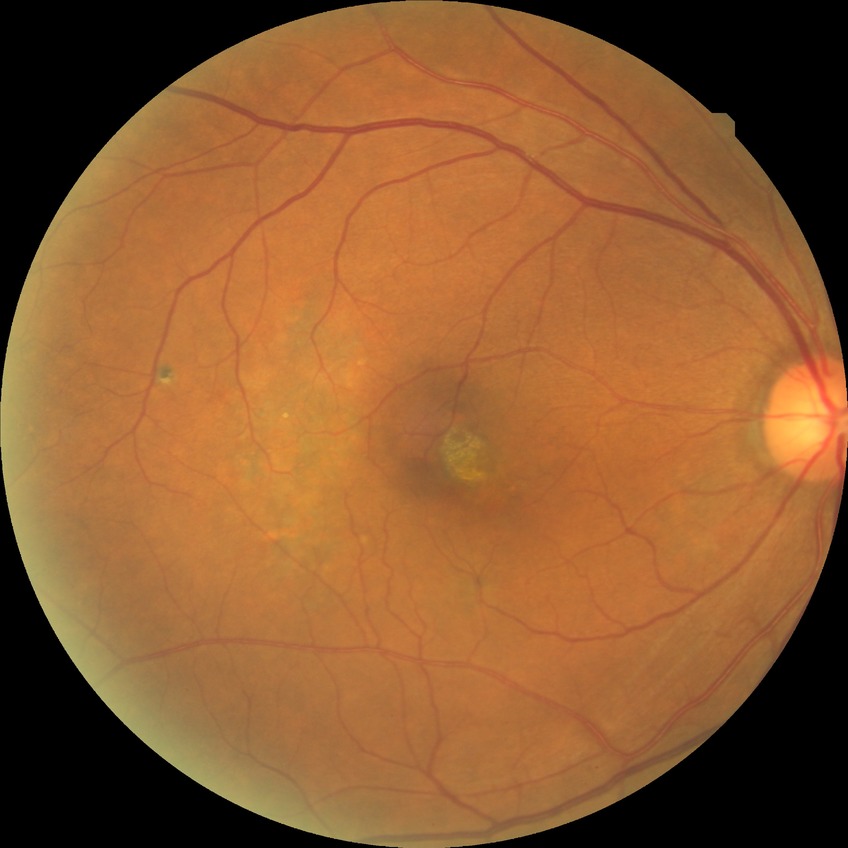 Assessment:
• Davis DR grade — NDR